Wide-field contact fundus photograph of an infant
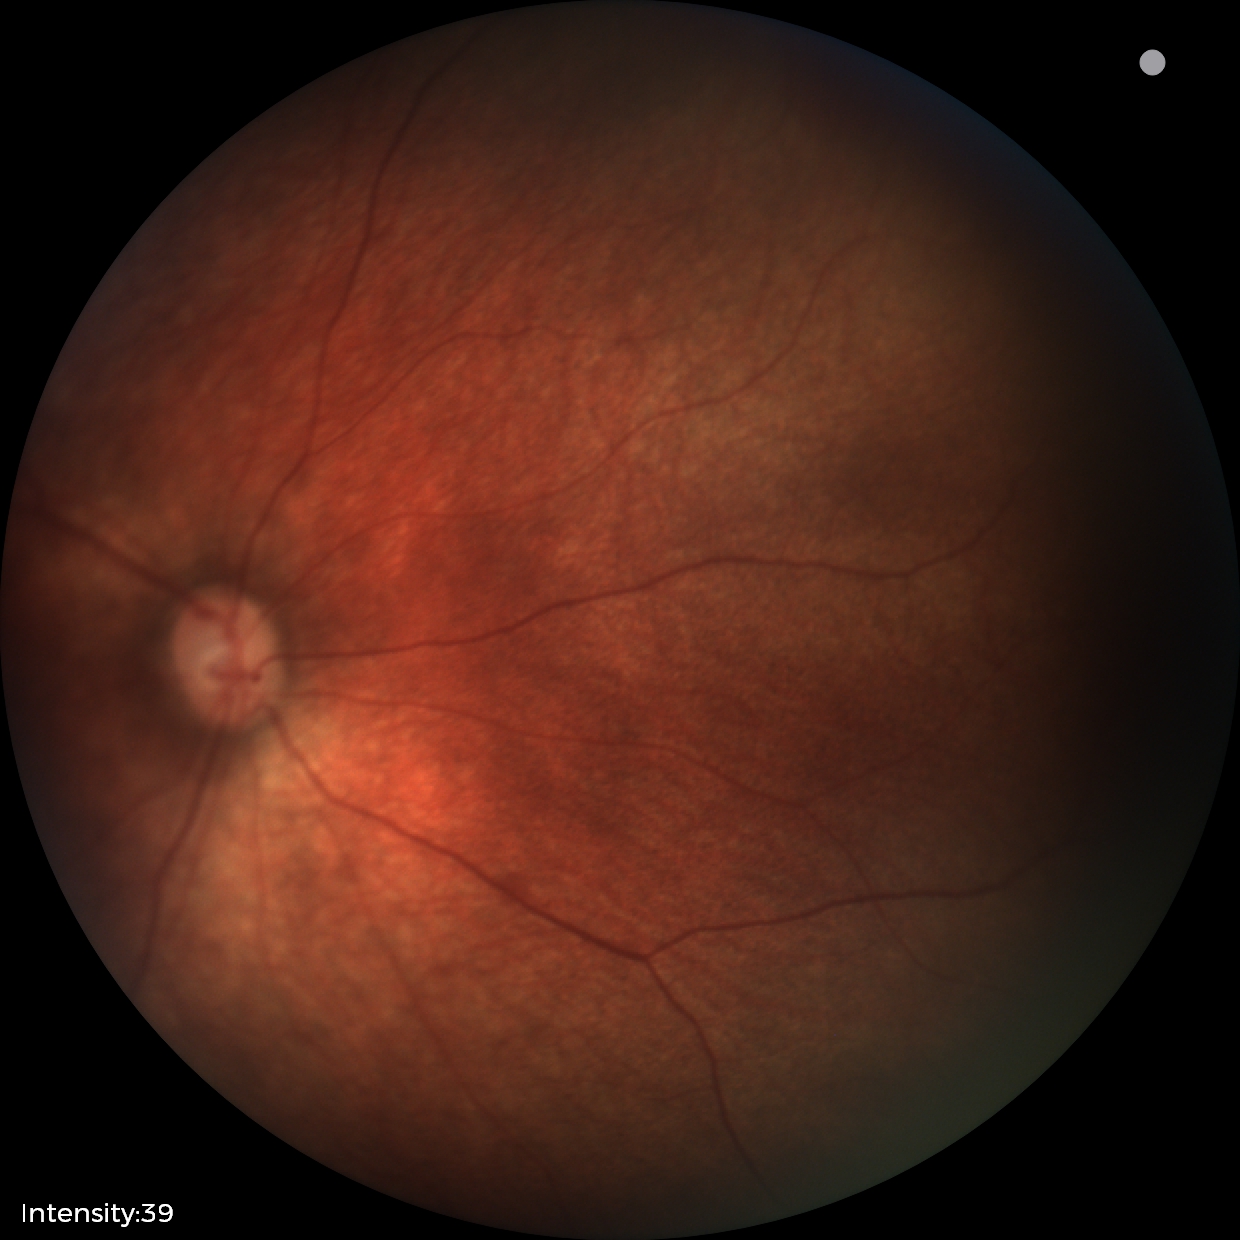
Screening examination diagnosed as physiological.